45° field of view. Color fundus photograph — 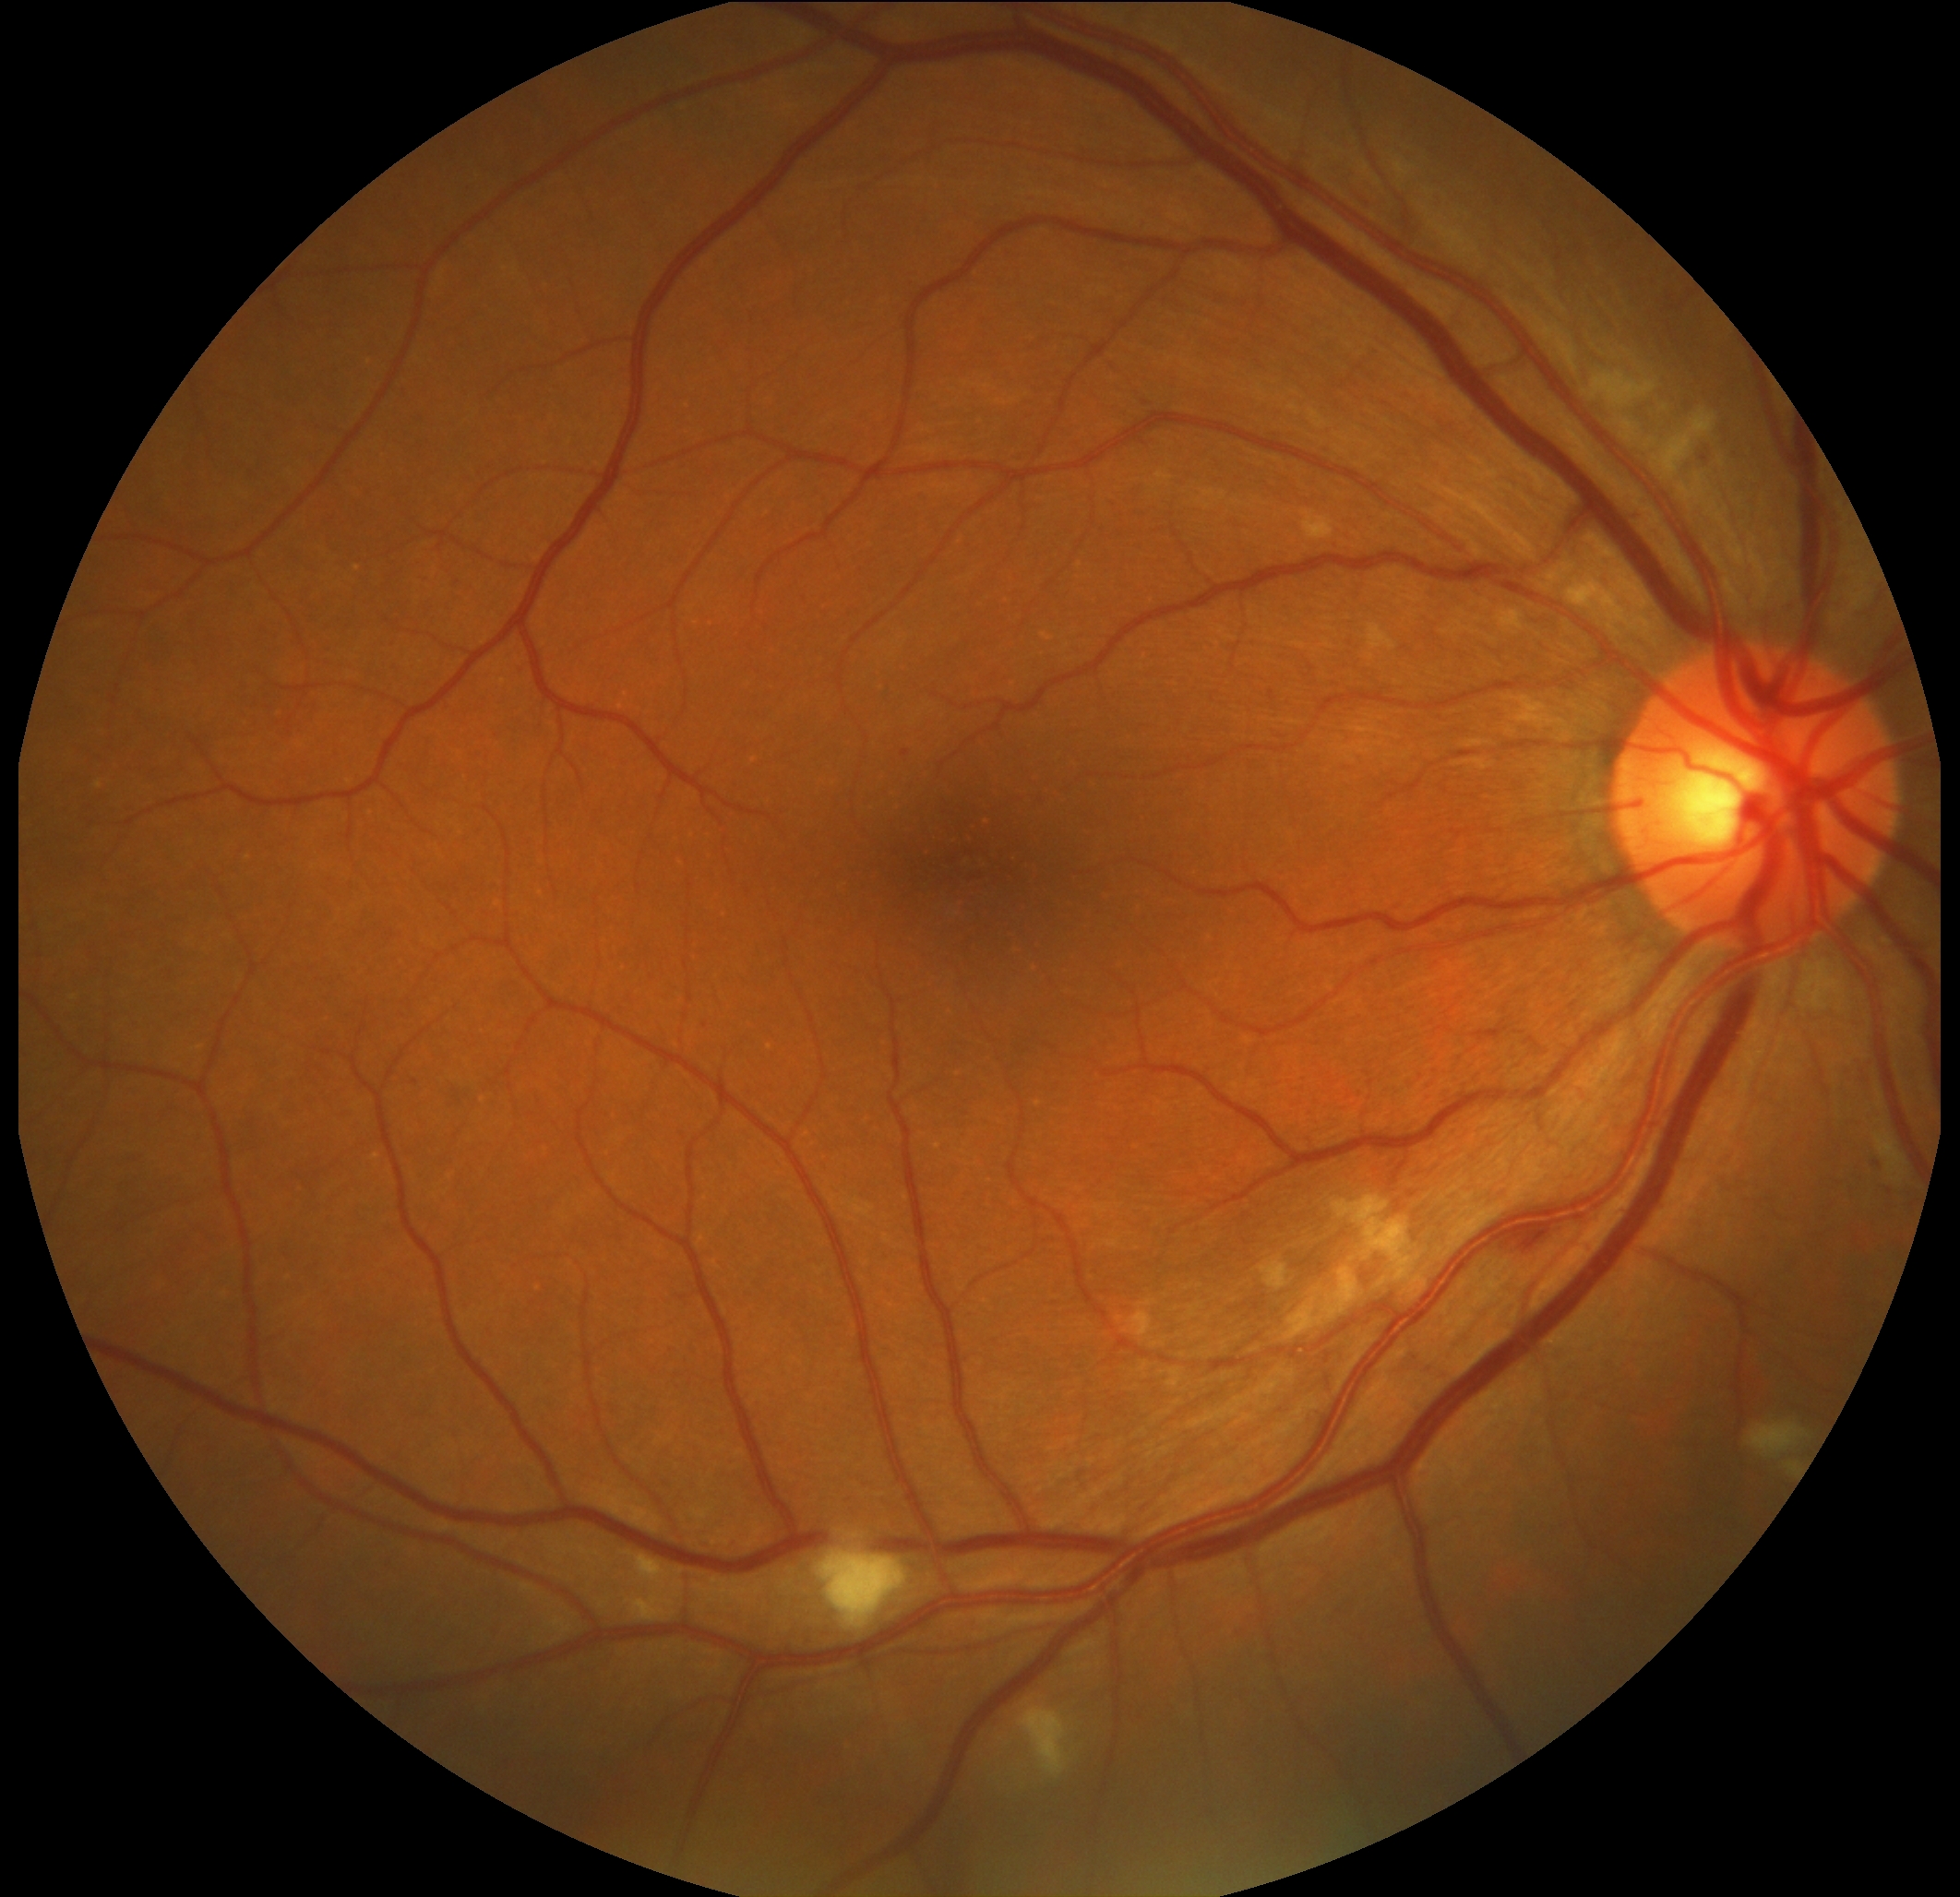 Diabetic retinopathy grade: 2/4.